CFP.
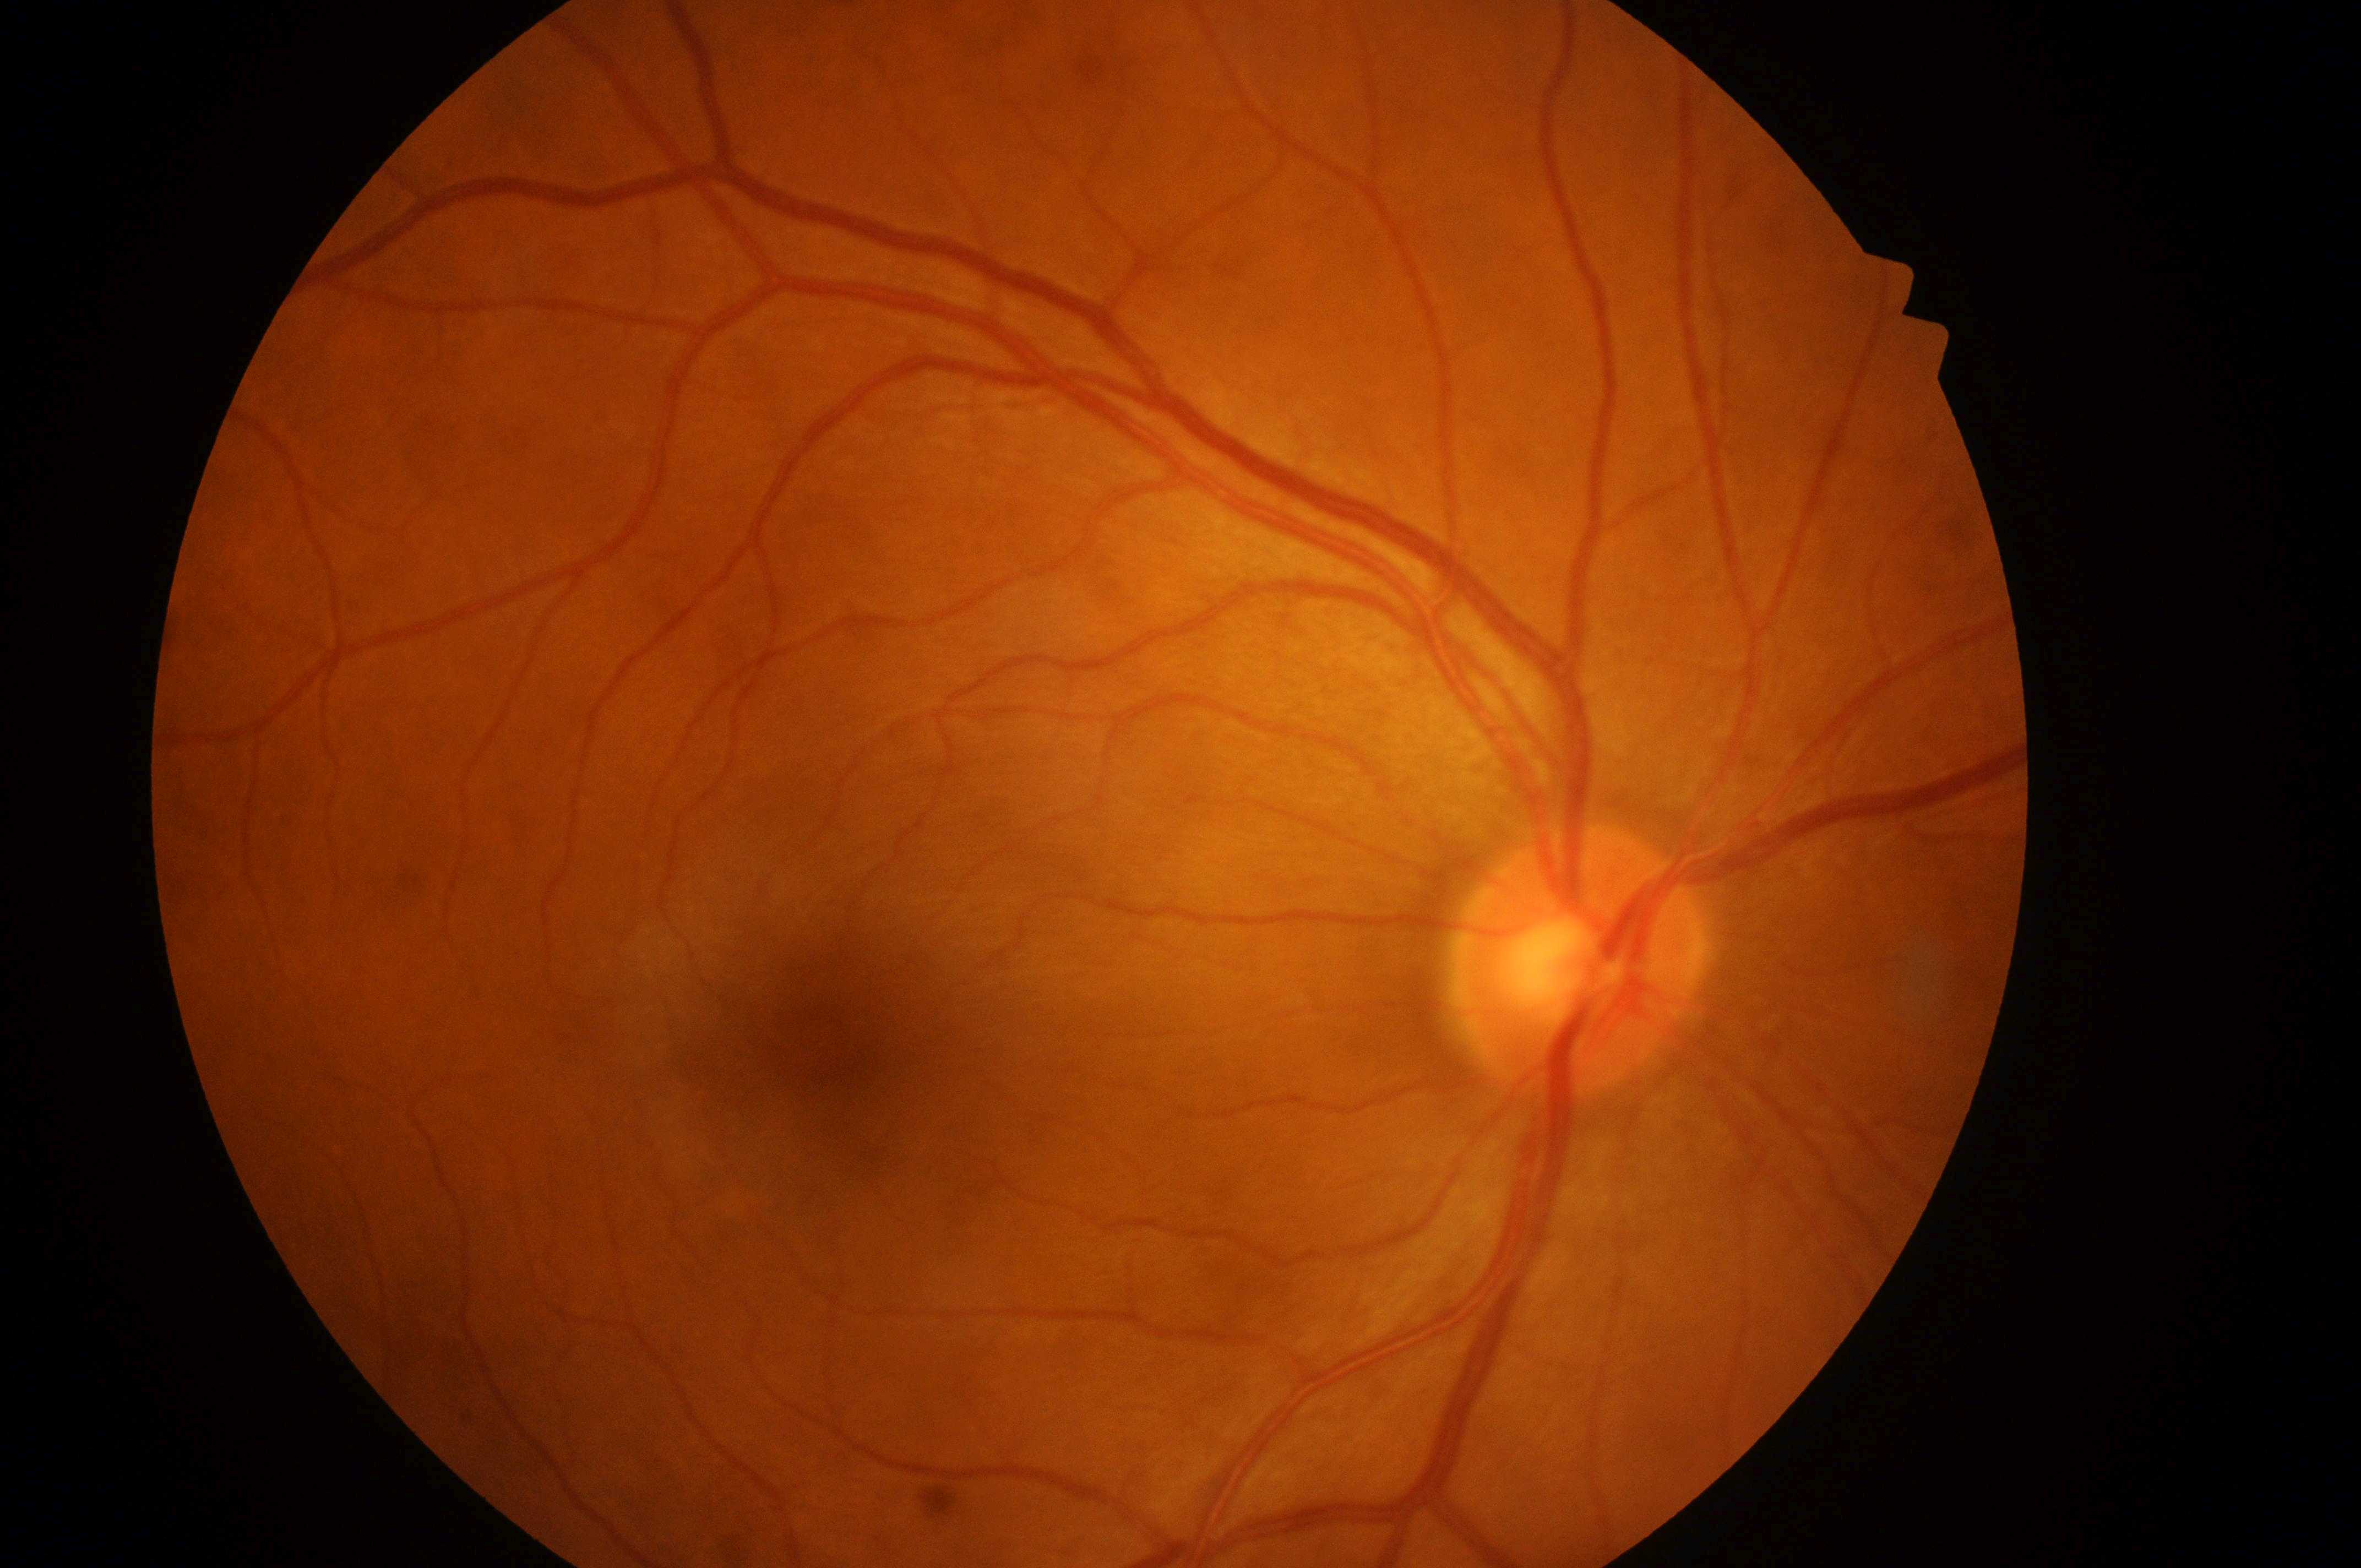

diabetic retinopathy = grade 0; fovea center = 823, 1043; laterality = oculus dexter; optic disk = 1574, 975; risk of diabetic macular edema = grade 0.